100° field of view (Phoenix ICON); Phoenix ICON wide-field infant fundus image: 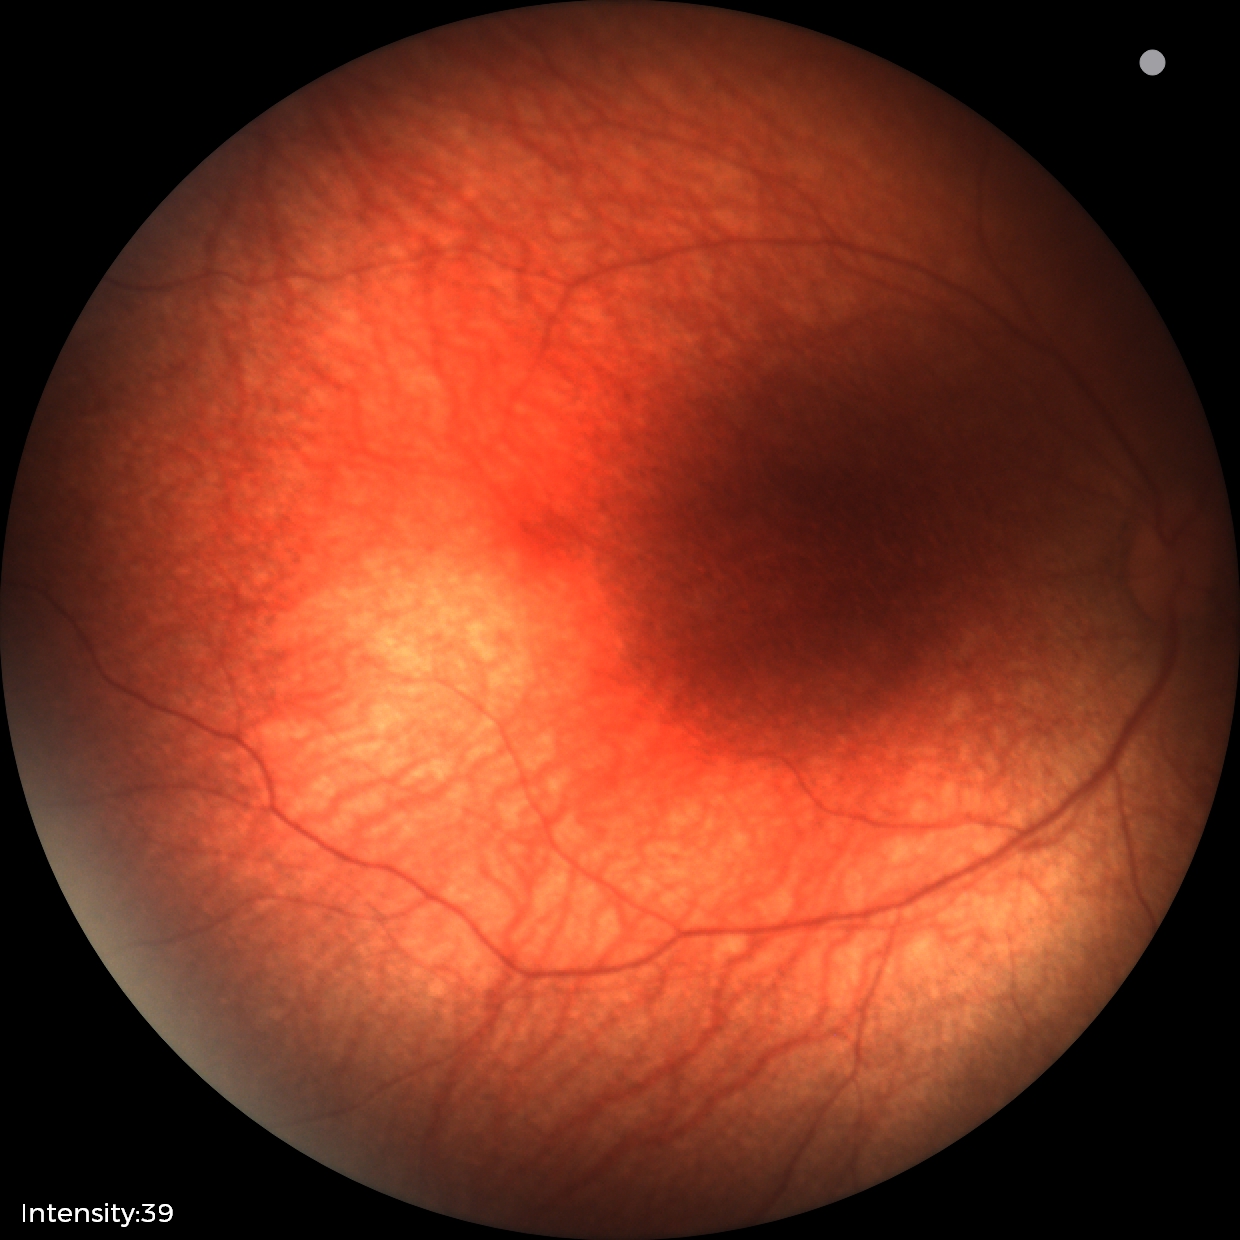
Physiological retinal appearance for postconceptual age.